45° FOV · 2212x1659 — 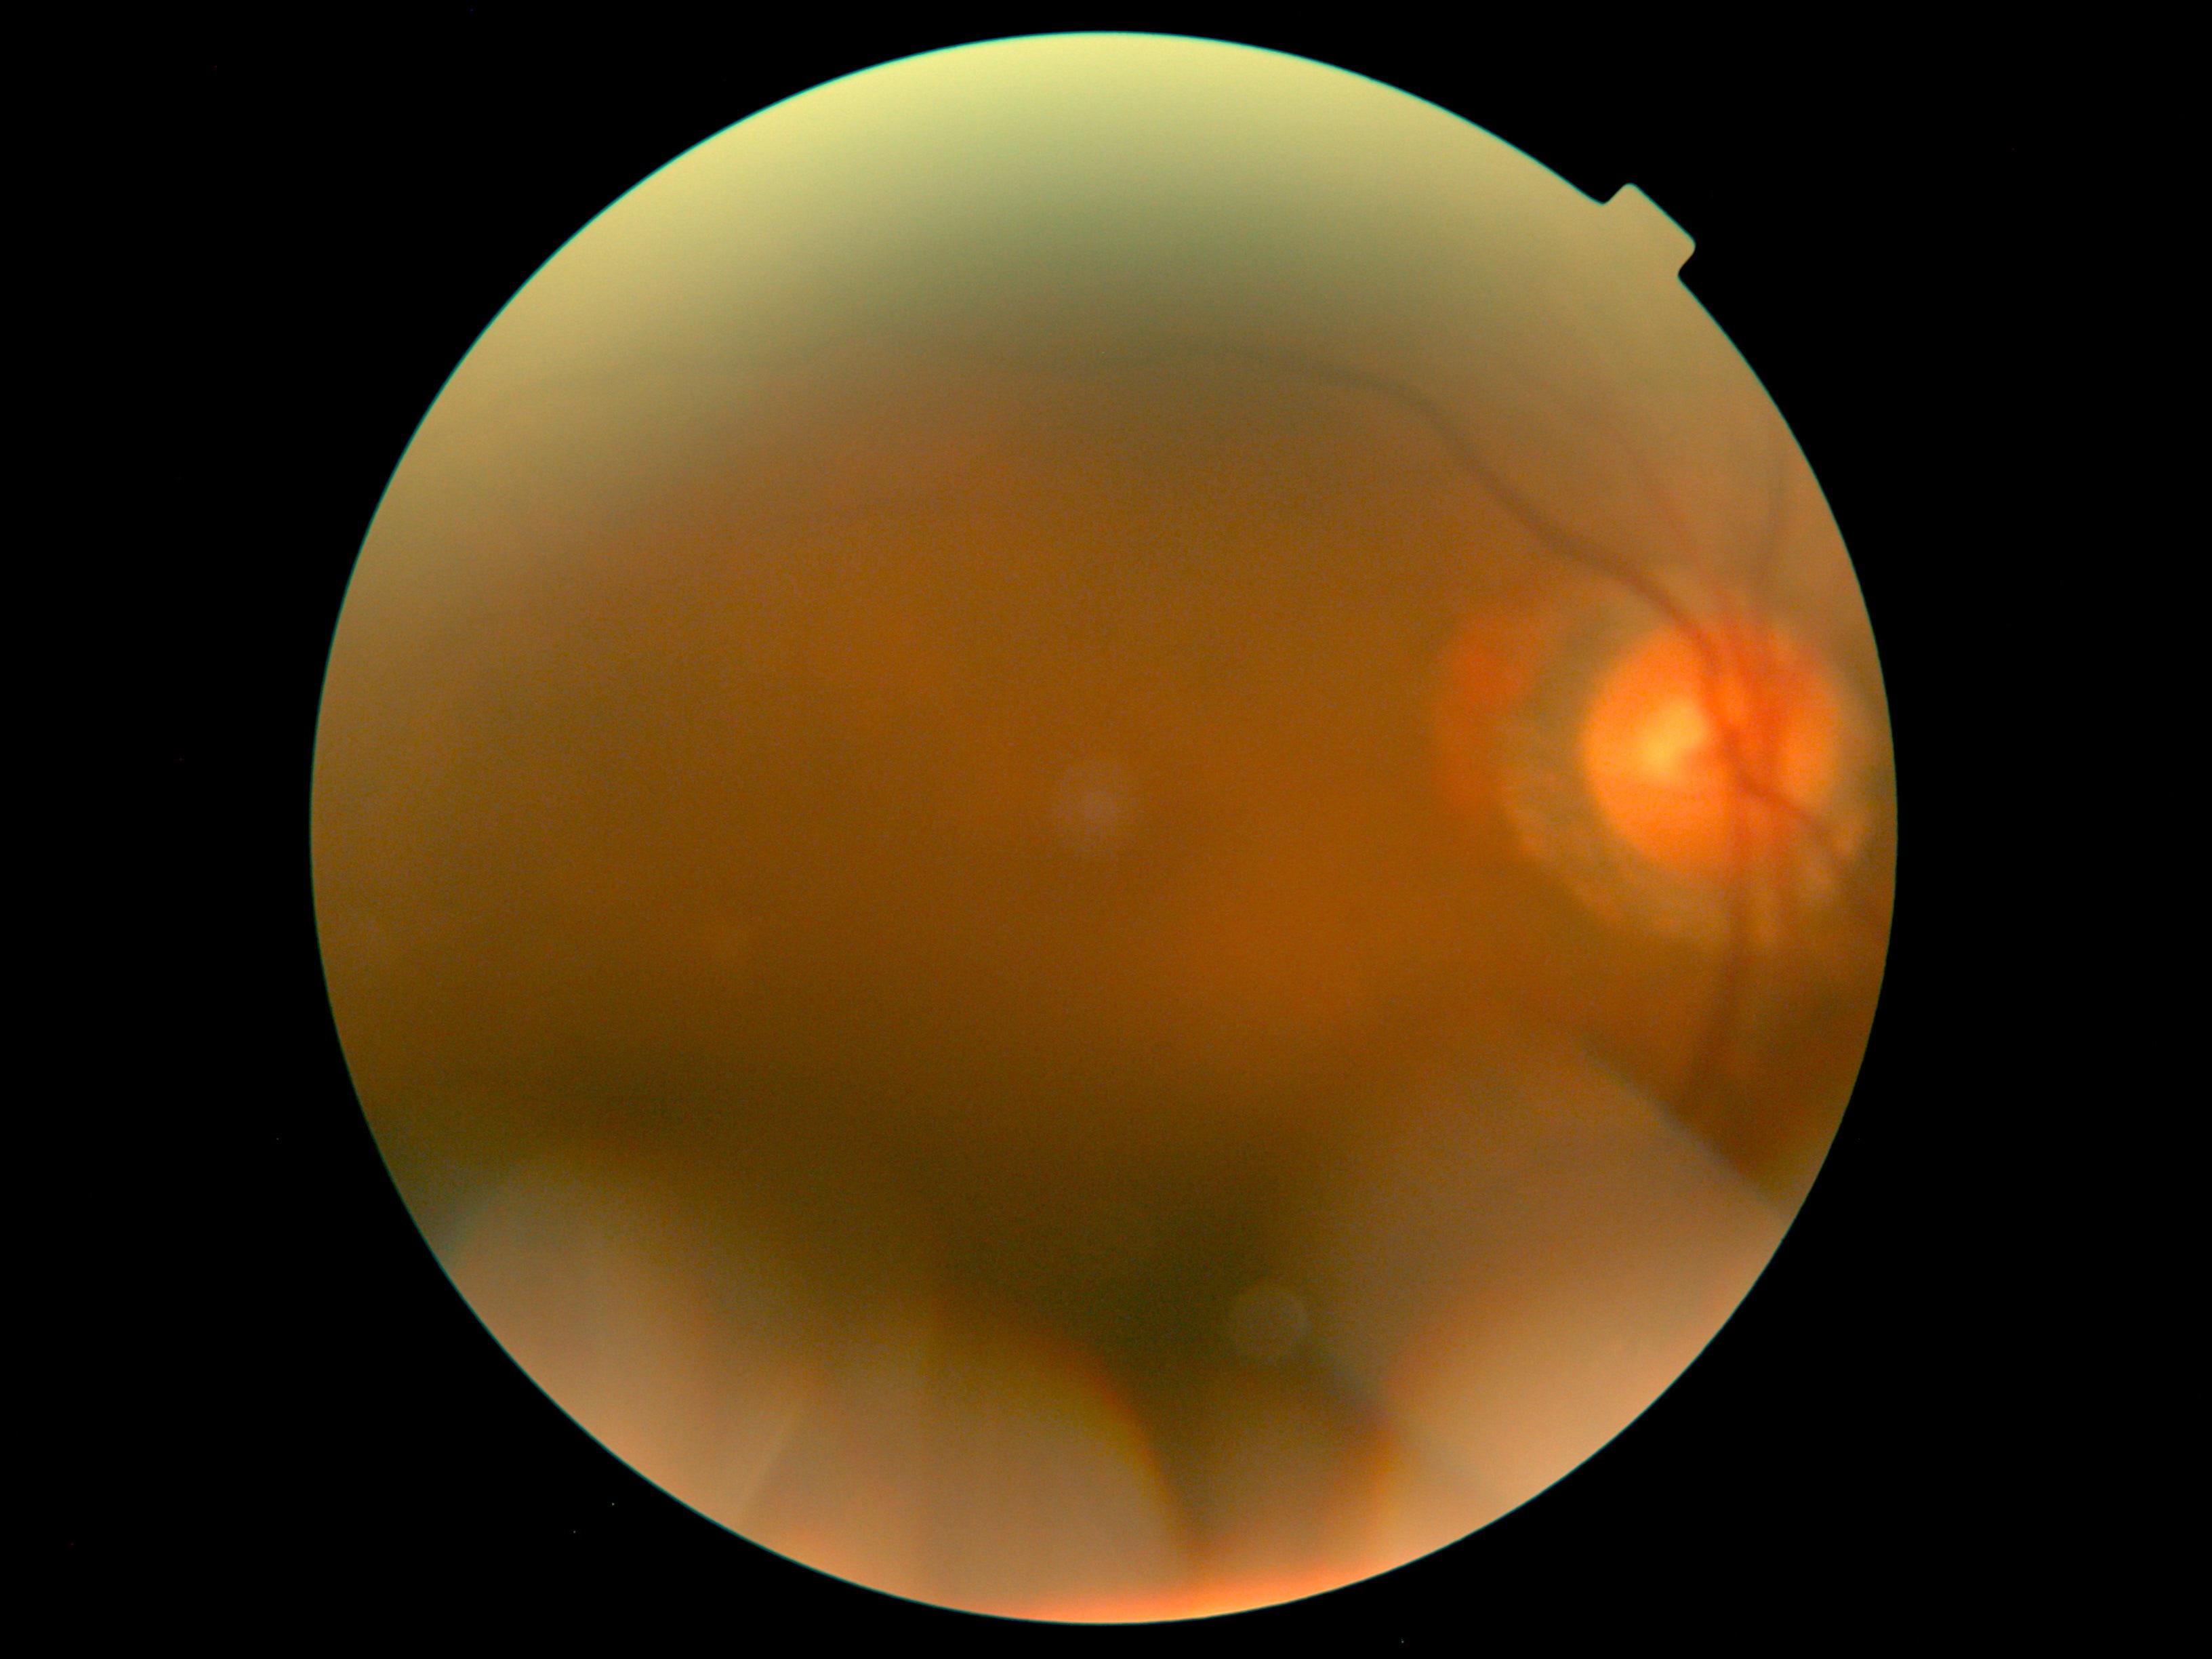

DR stage: ungradable due to poor image quality.